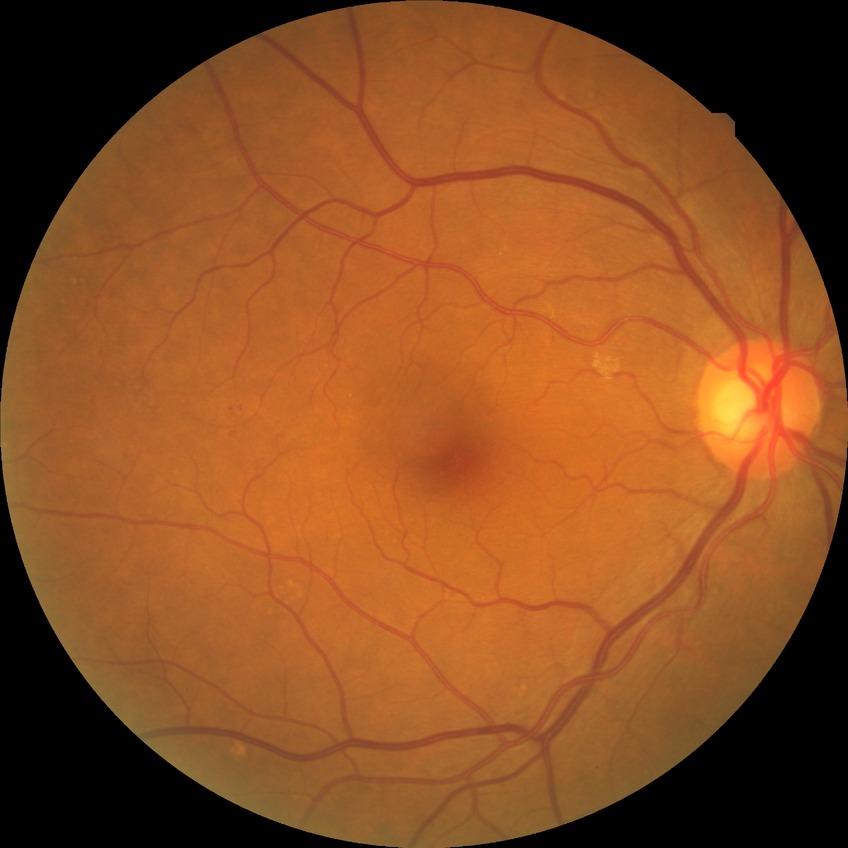 dr_impression: no DR findings
davis_grade: NDR